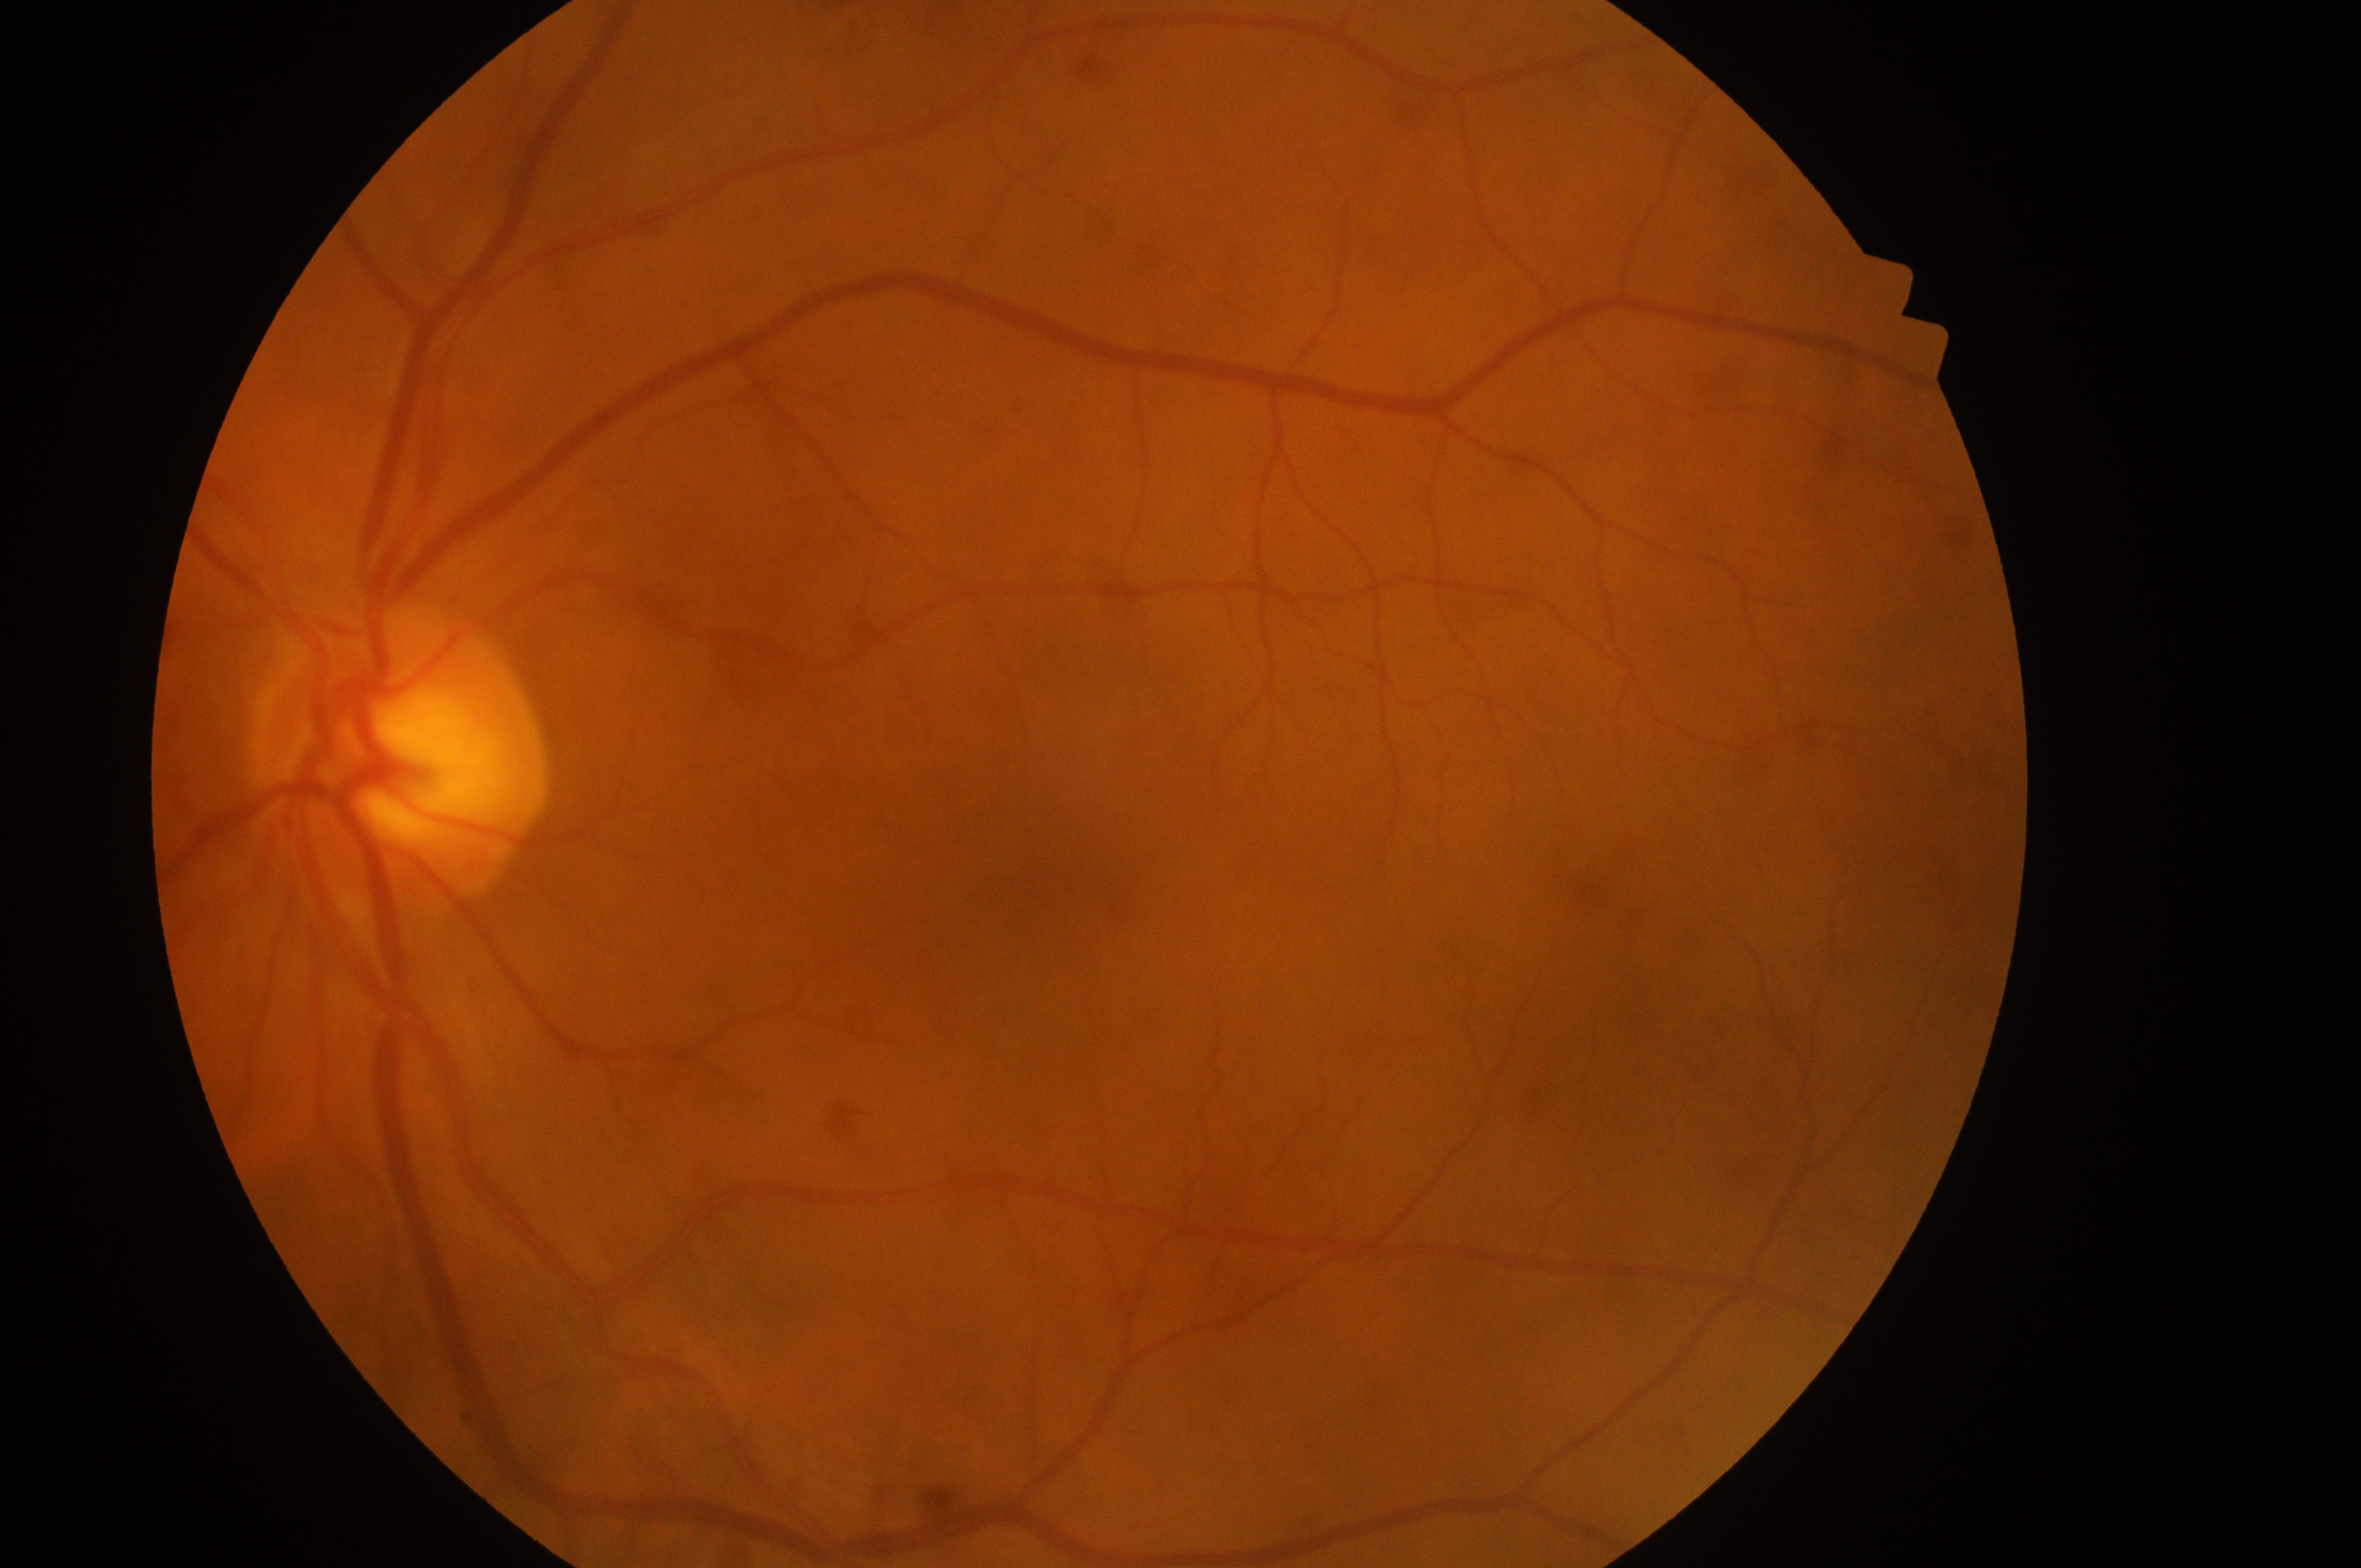 Diabetic retinopathy: grade 0 (no apparent retinopathy). Optic disc center: (400, 773). Foveal center: (1054, 899). No DR or DME findings. Macular edema: no risk (grade 0). This is the left eye.